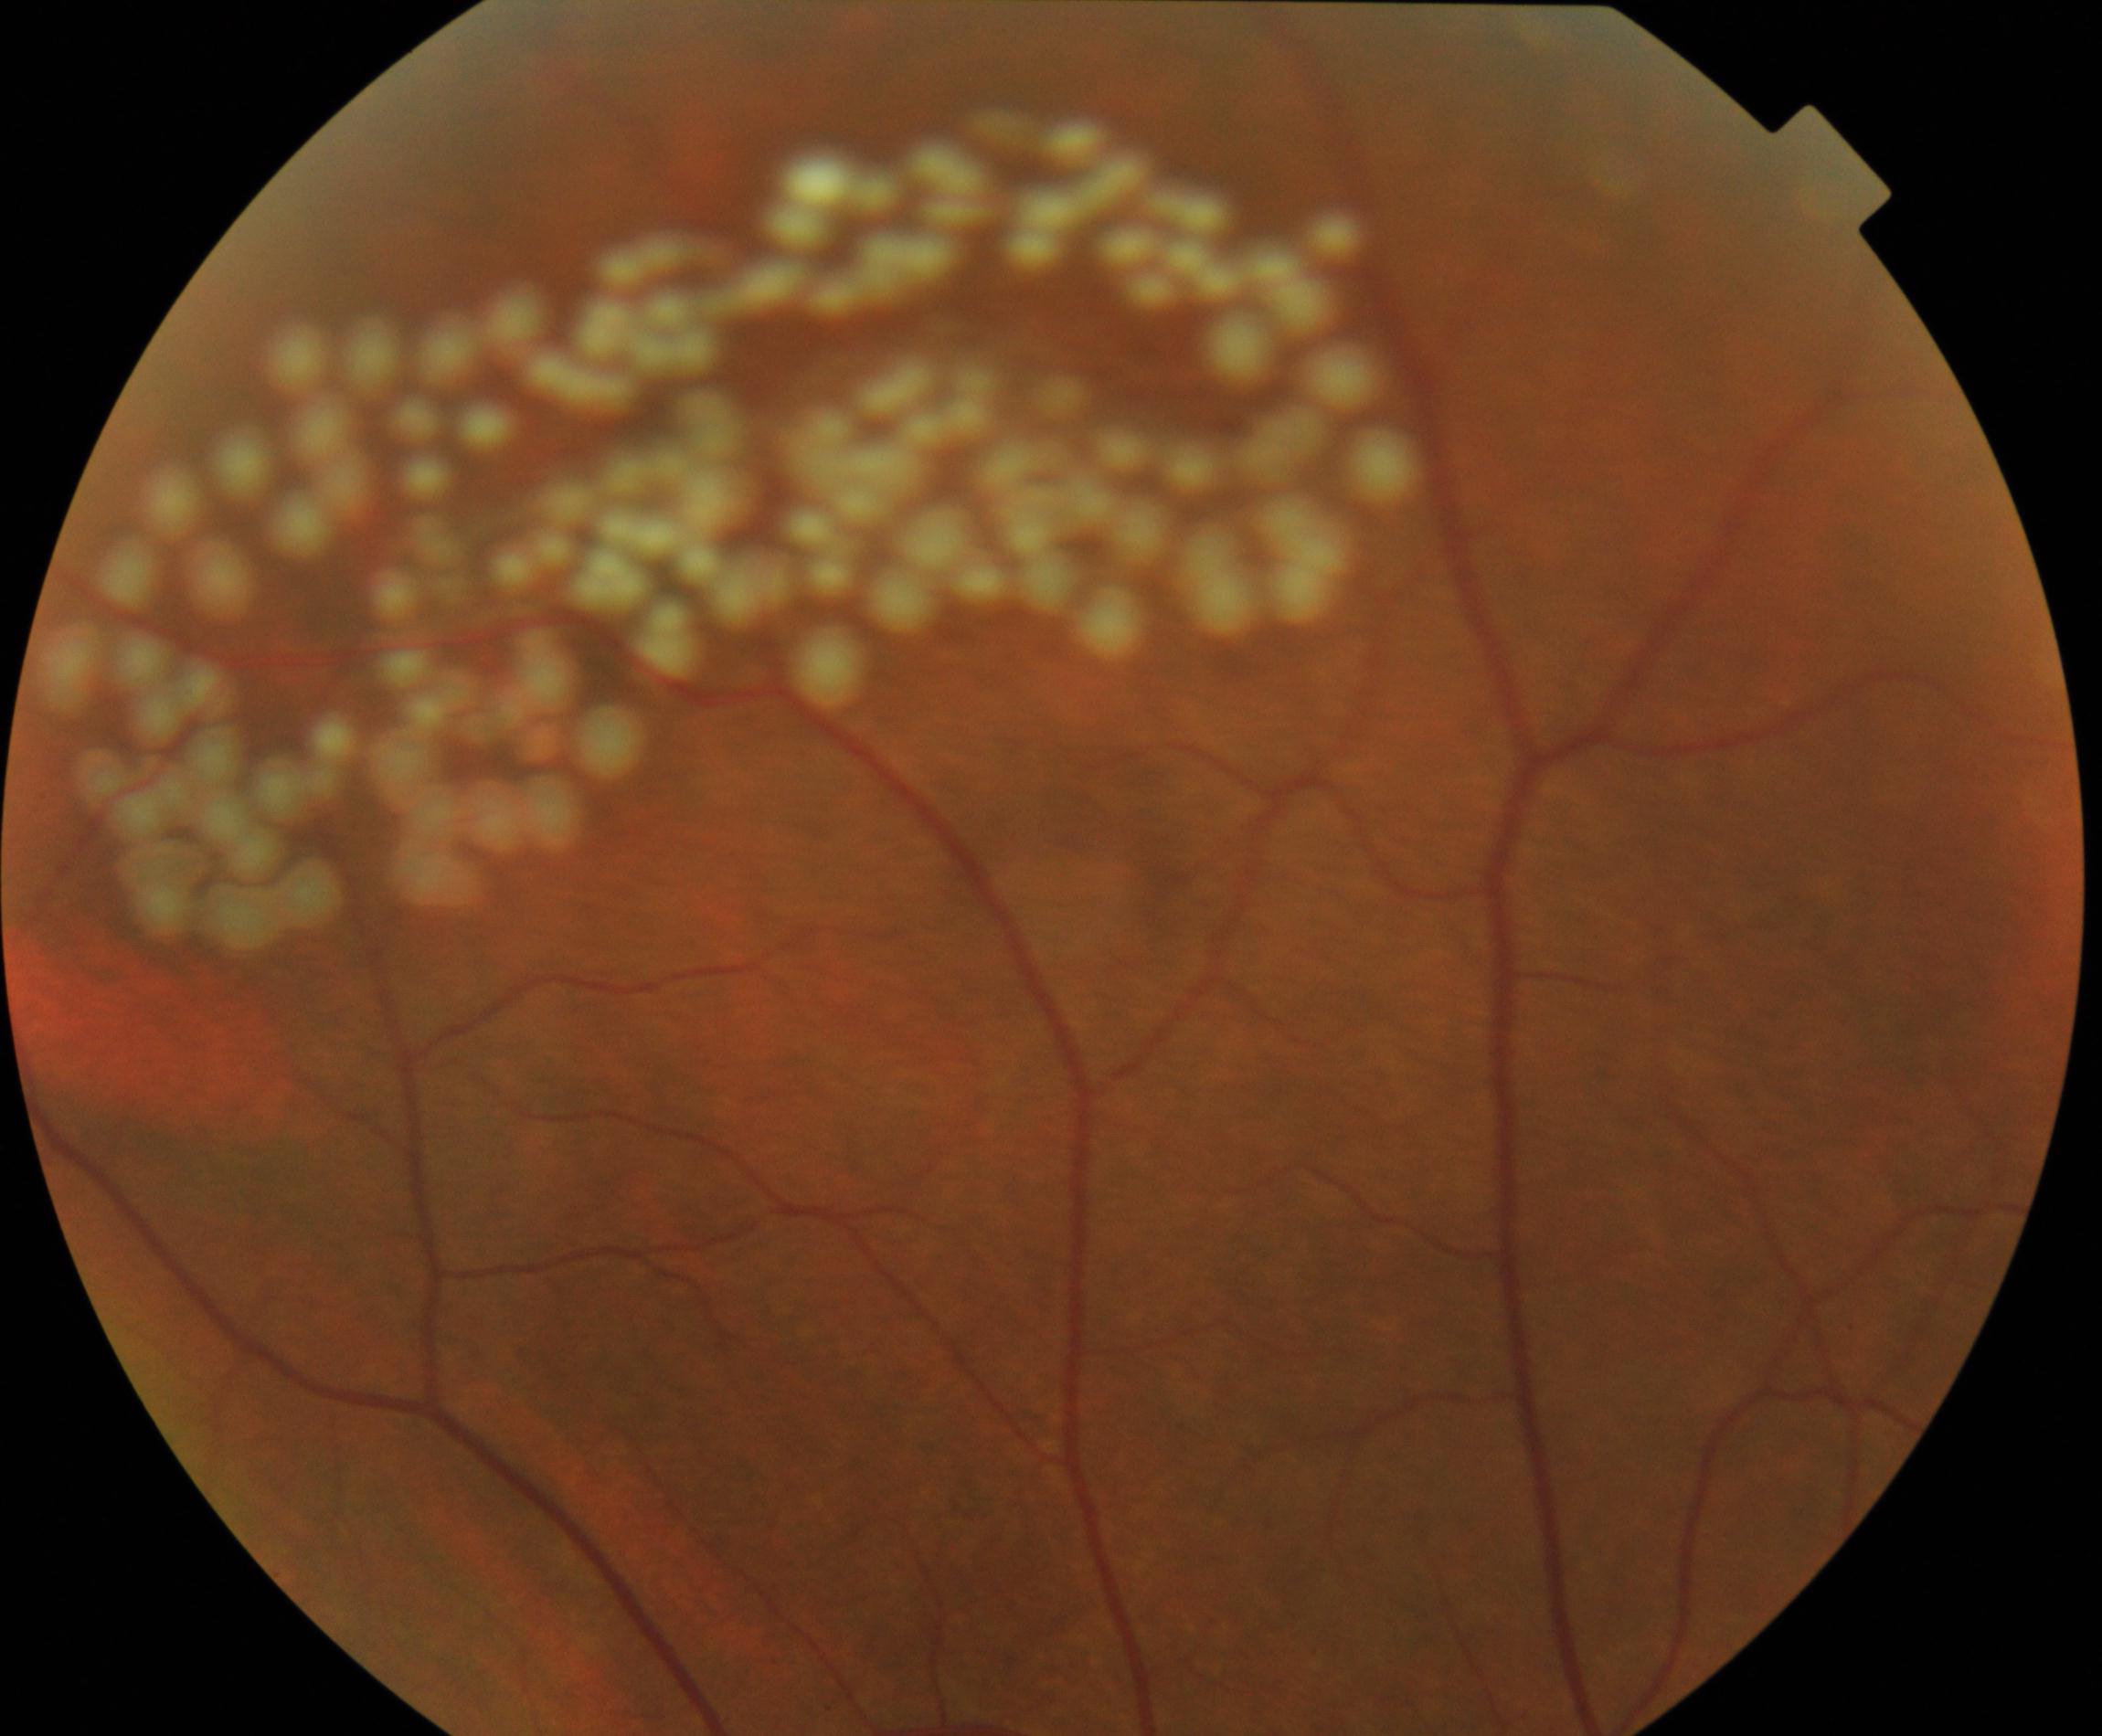
This fundus photograph shows laser spots.